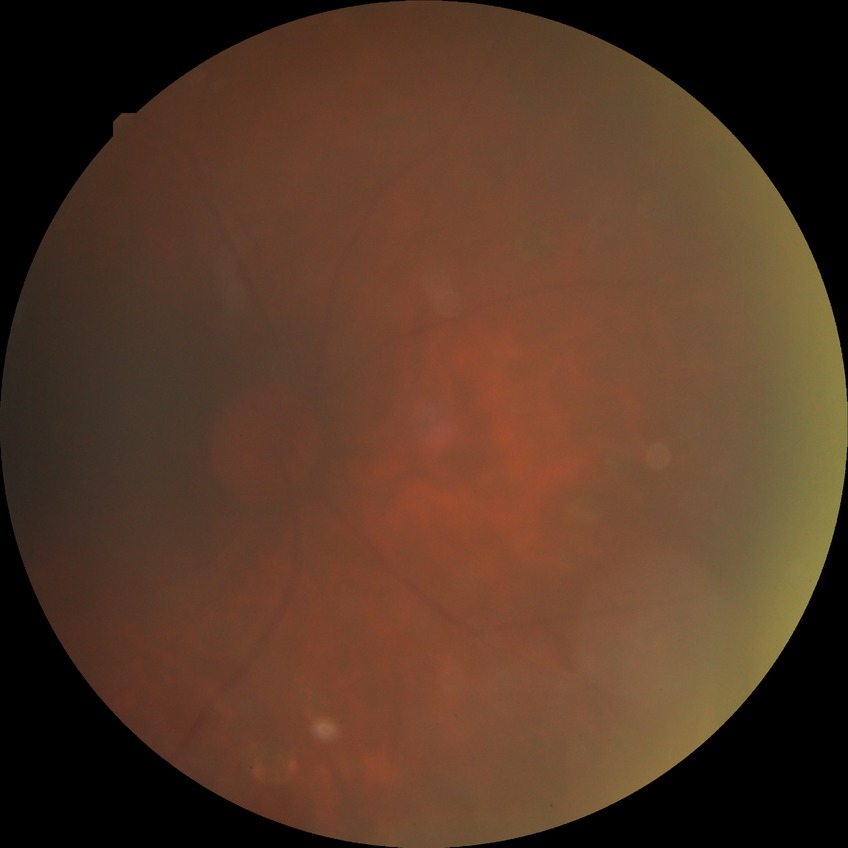 Findings:
– diabetic retinopathy stage: proliferative diabetic retinopathy